FOV: 45 degrees — 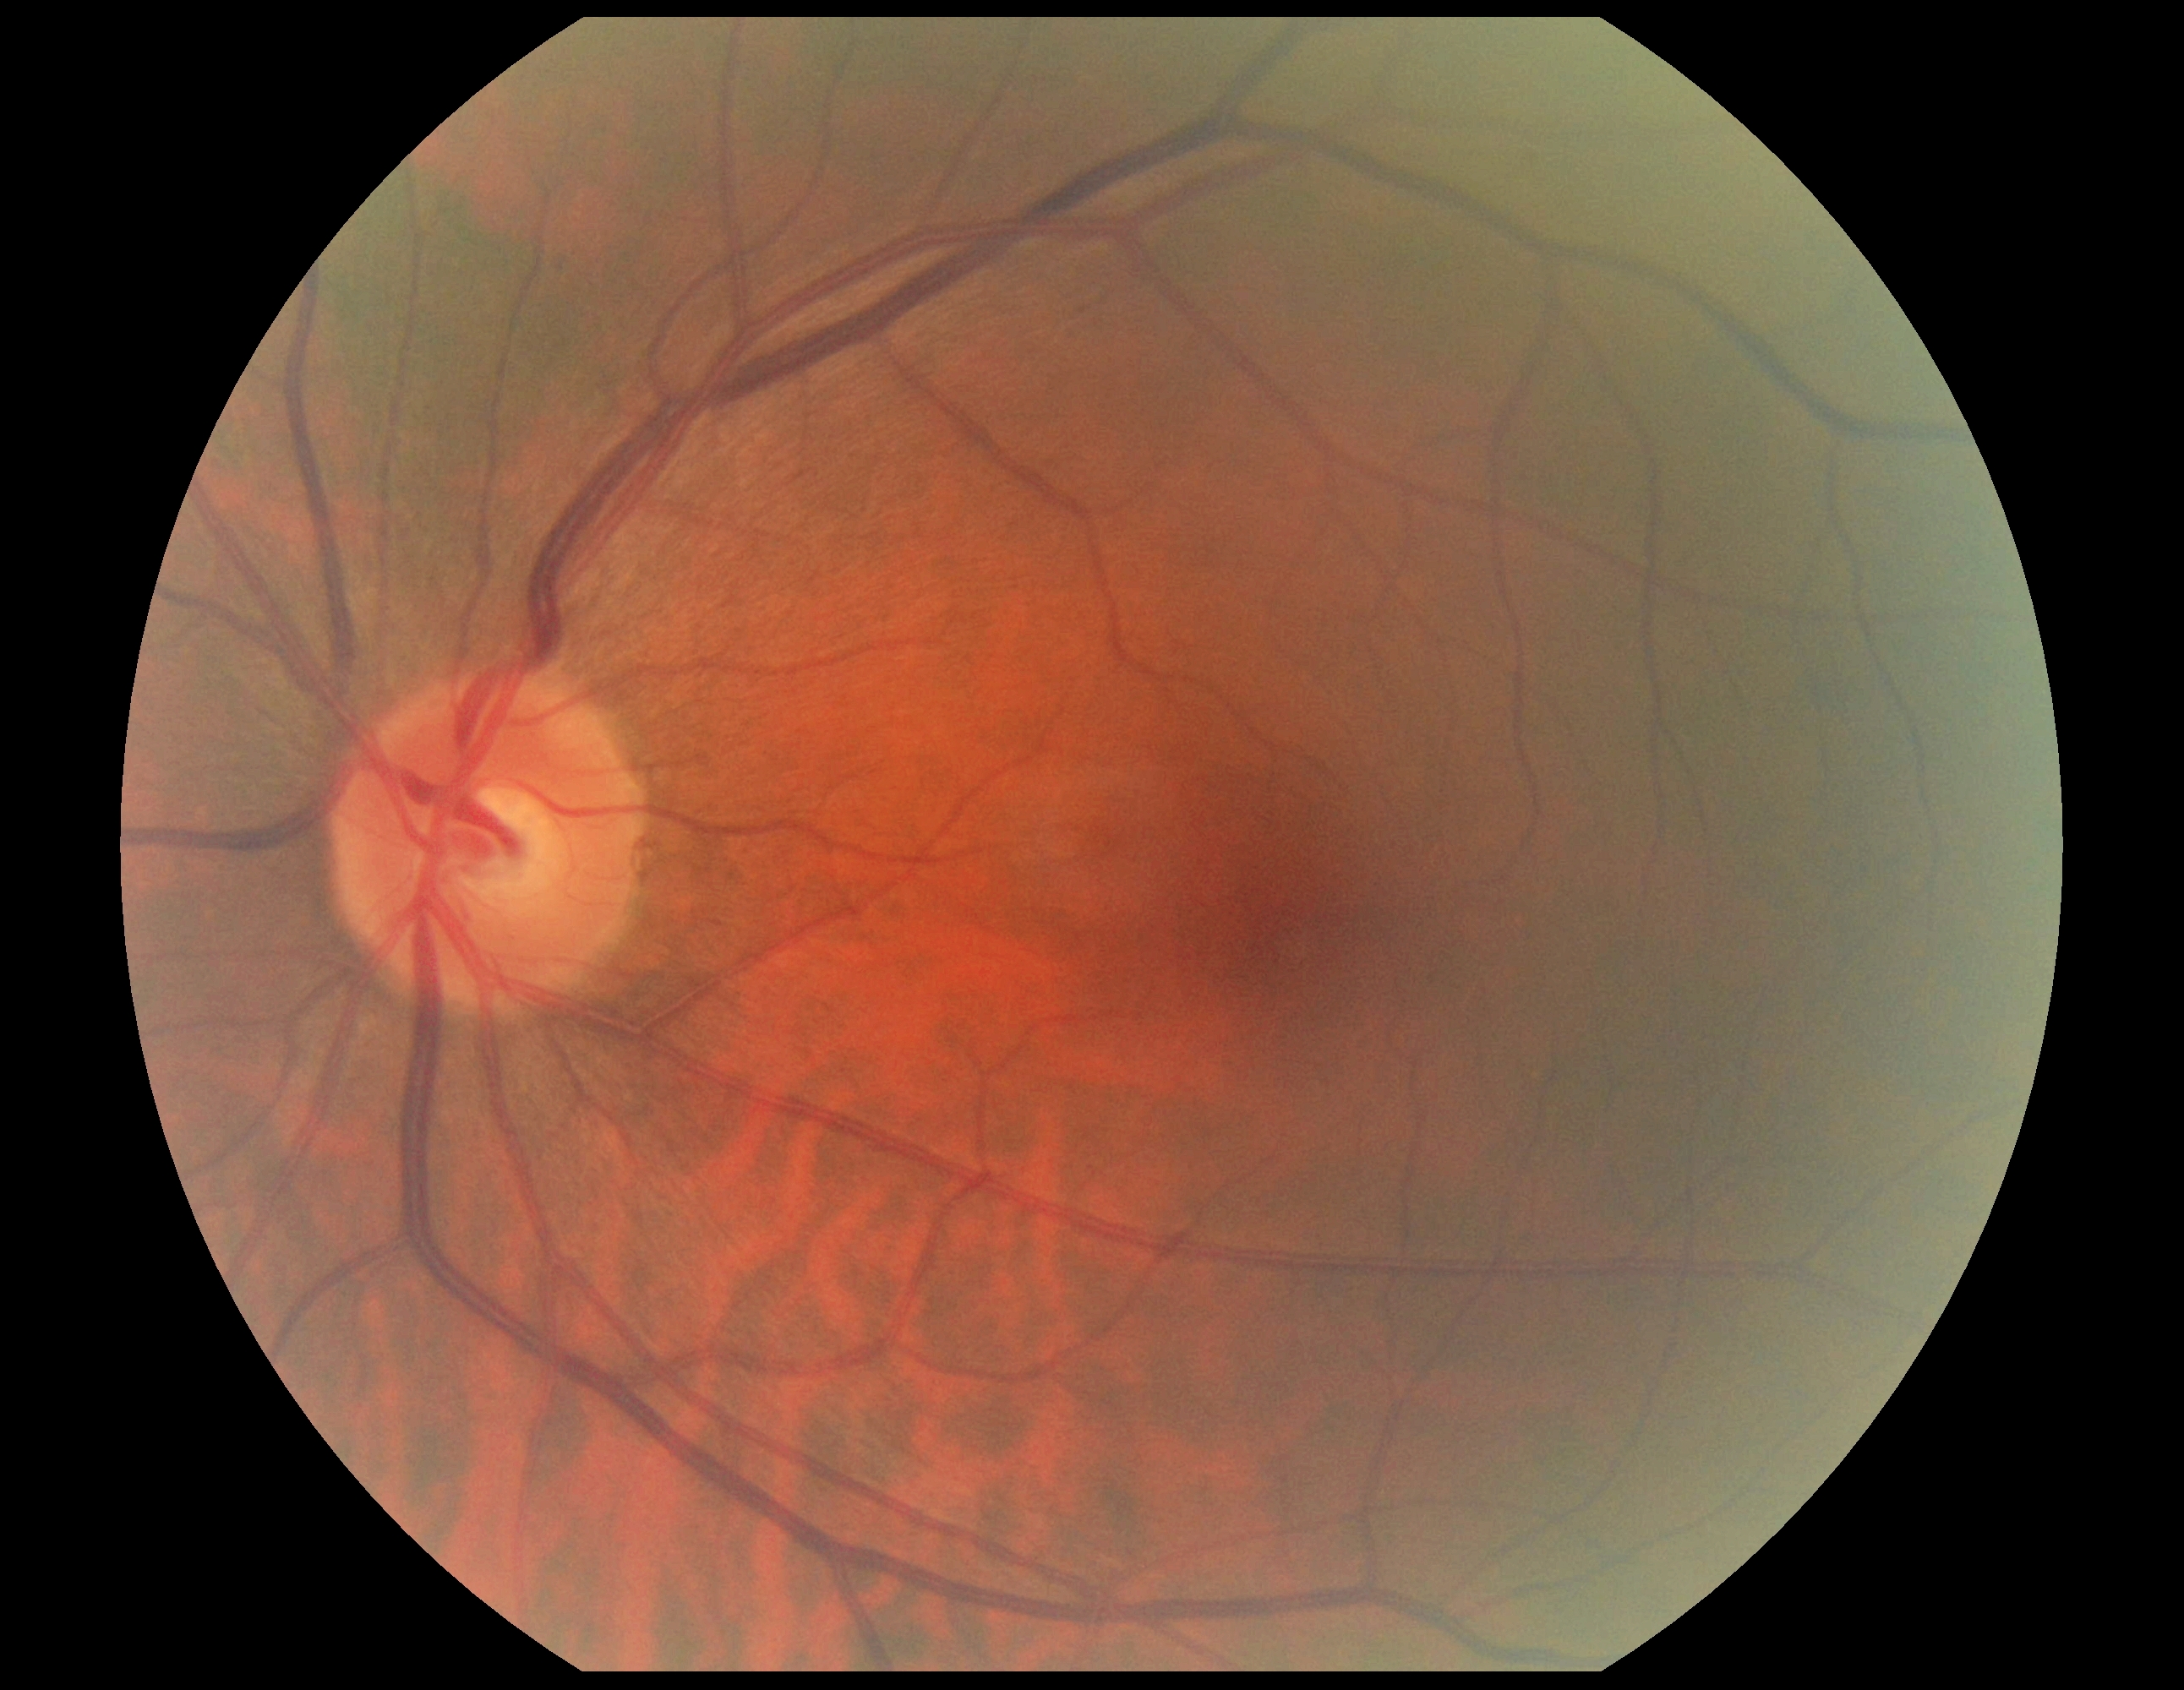 DR stage: no apparent diabetic retinopathy (grade 0).